Posterior pole photograph:
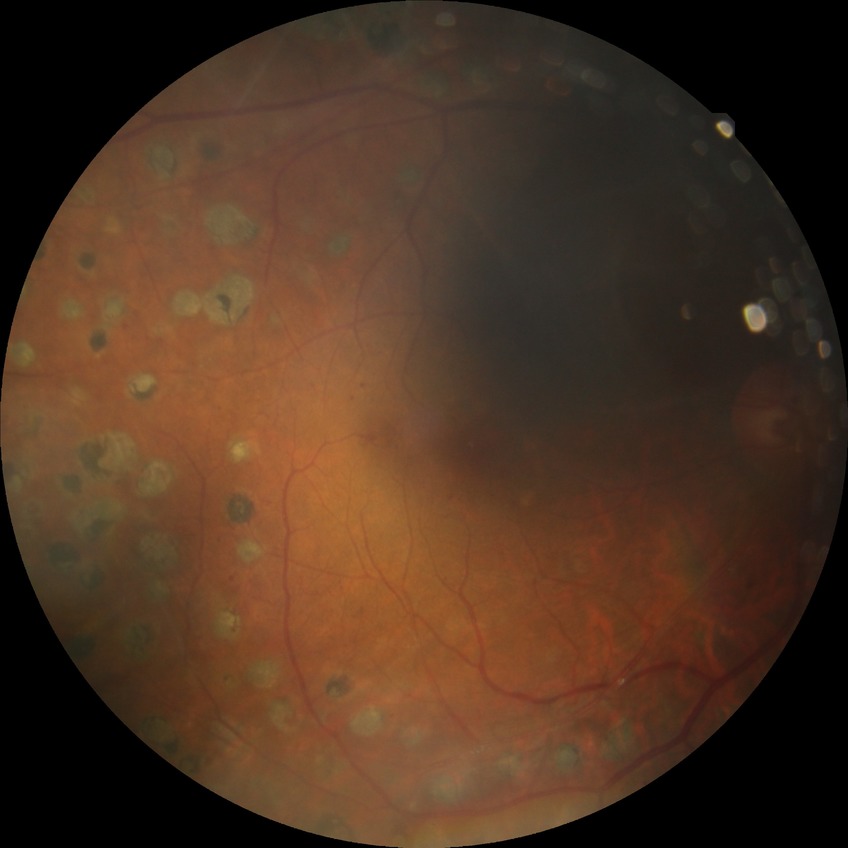

Diabetic retinopathy grade is proliferative diabetic retinopathy.